Nonmydriatic — 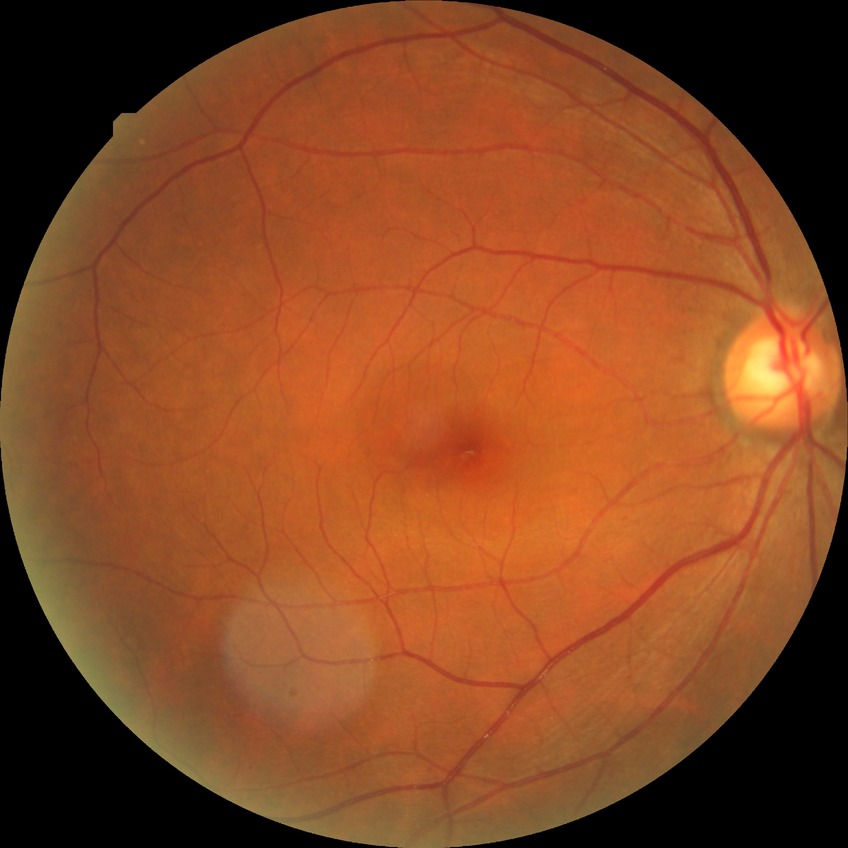

Diabetic retinopathy (DR): no diabetic retinopathy (NDR).